Infant wide-field fundus photograph:
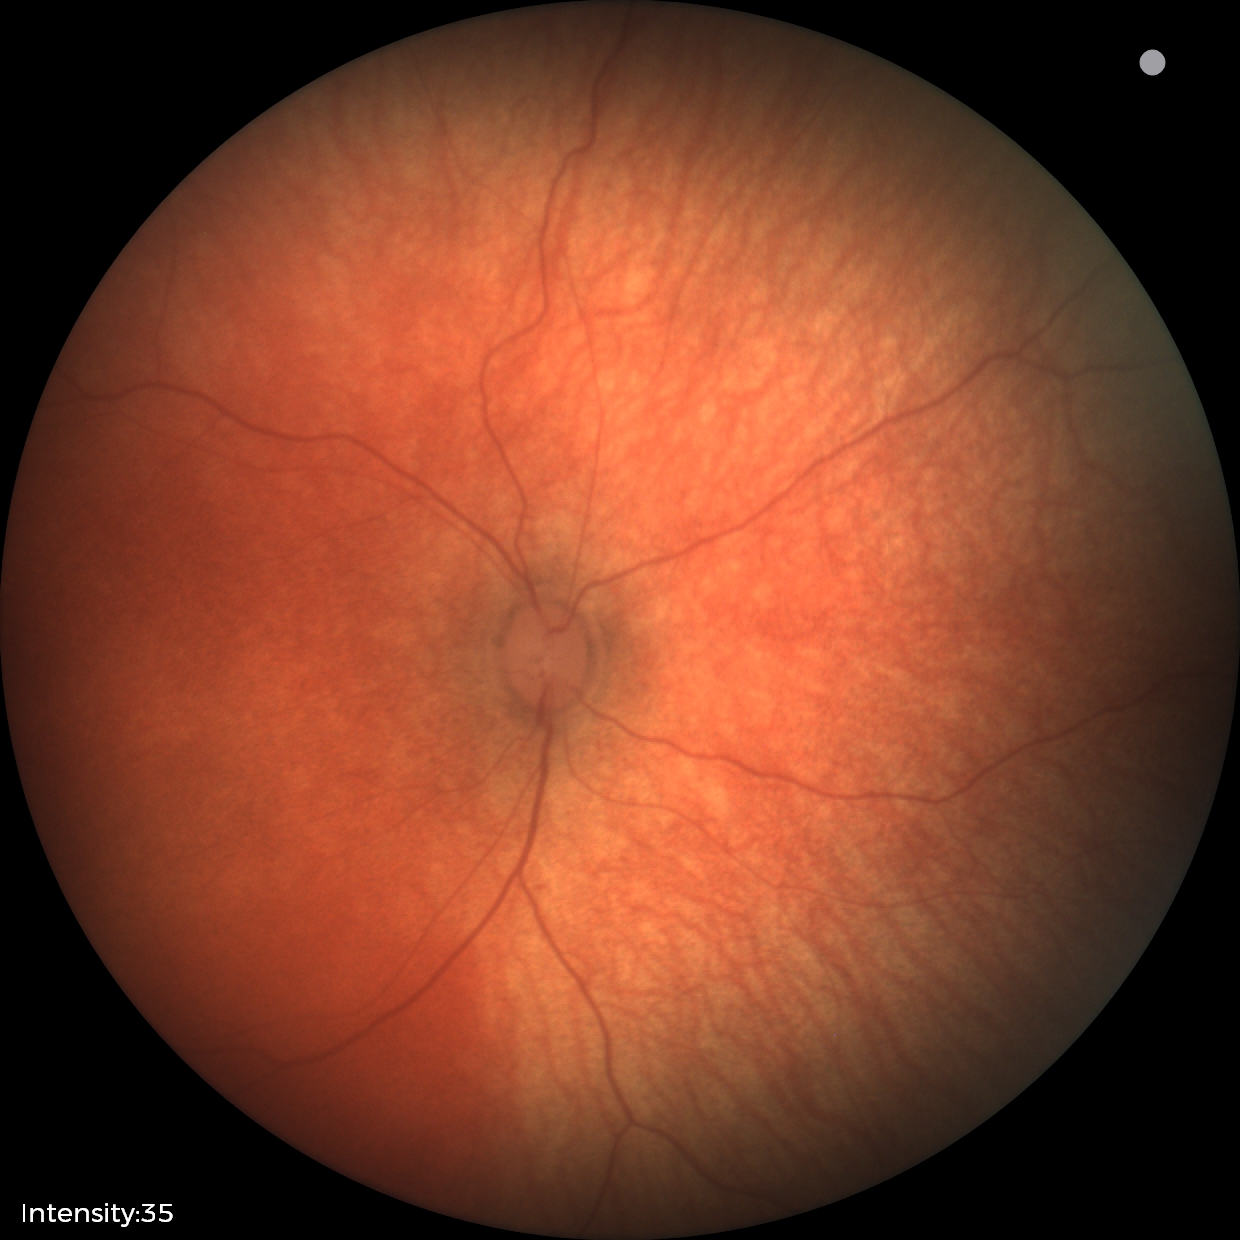

Normal screening examination.